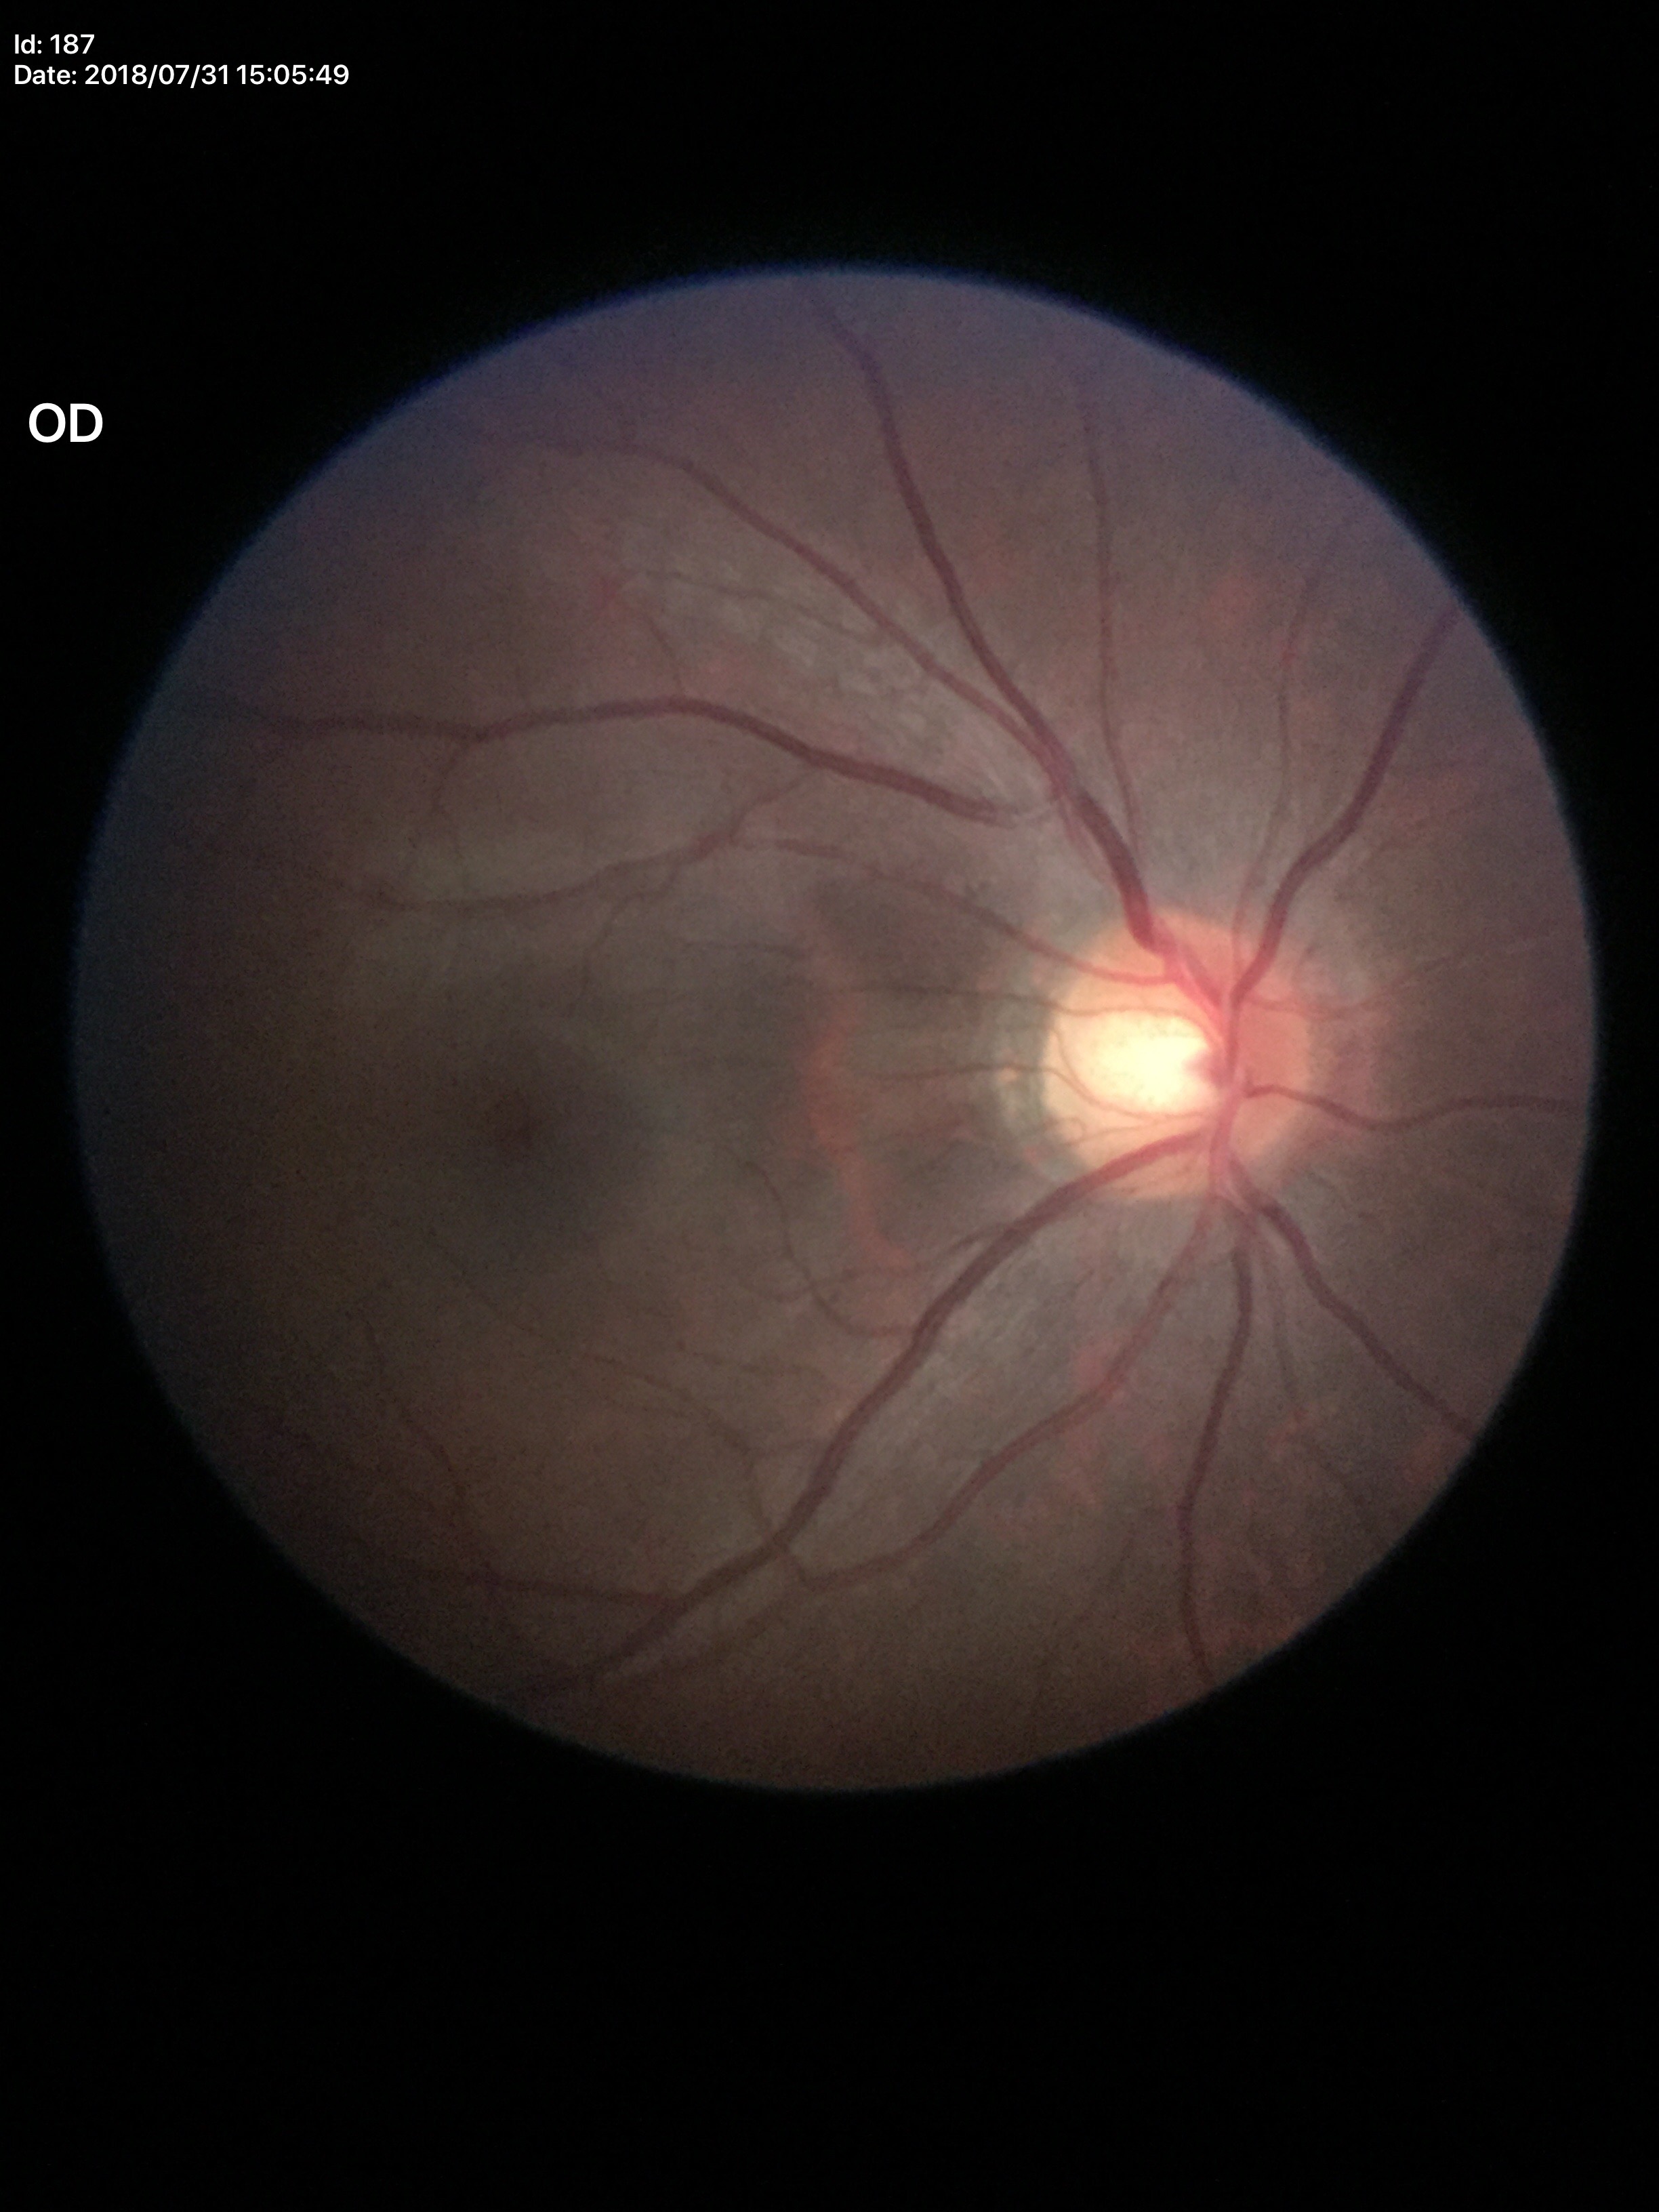 Negative for glaucoma suspicion. Vertical cup-to-disc ratio (VCDR): 0.57. Horizontal cup-to-disc ratio (HCDR): 0.60.